Acquired with a NIDEK AFC-230; modified Davis grading:
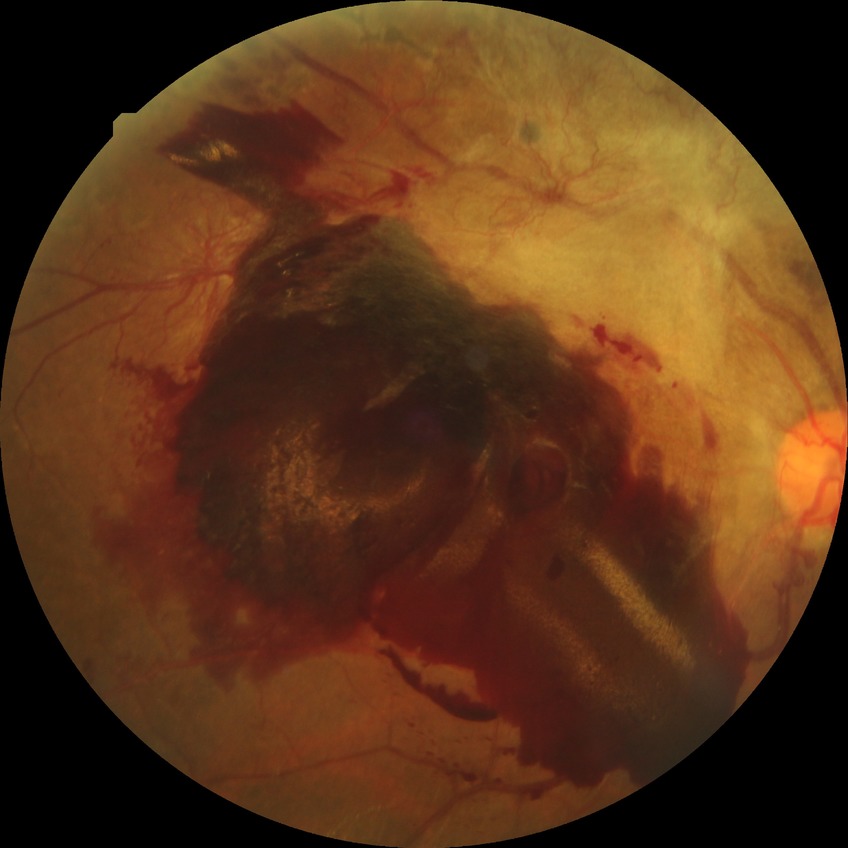
Diabetic retinopathy (DR) is proliferative diabetic retinopathy (PDR).